Wide-field fundus image from infant ROP screening.
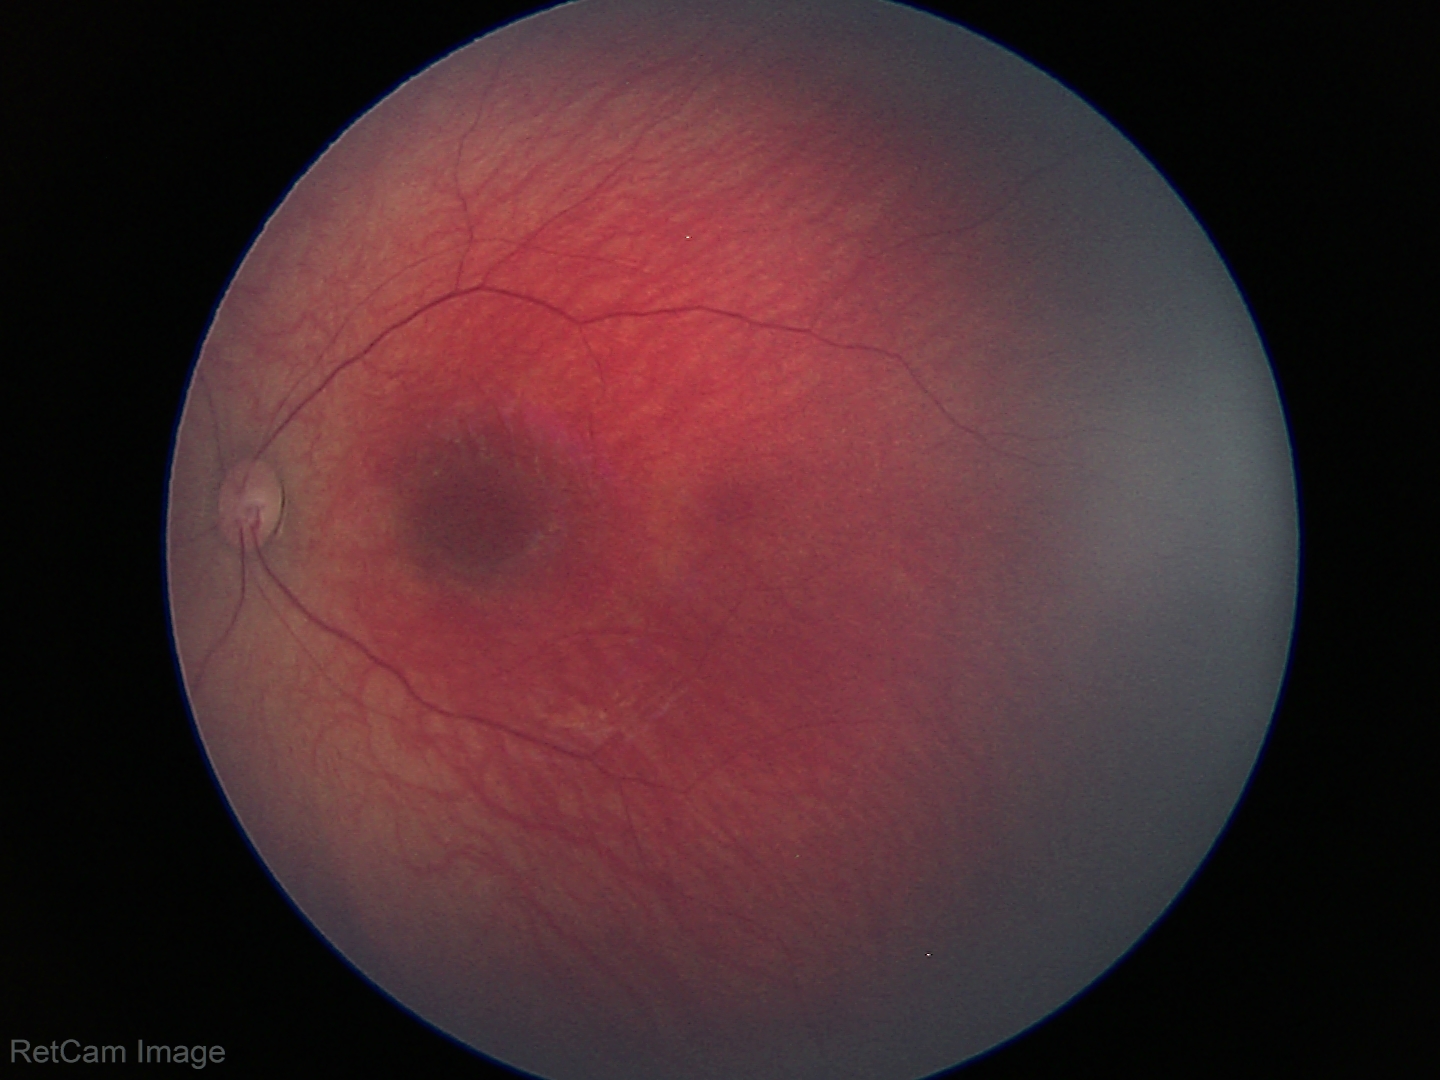
Screening examination with no abnormal retinal findings.